Acquired on the Clarity RetCam 3; pediatric retinal photograph (wide-field); 640x480: 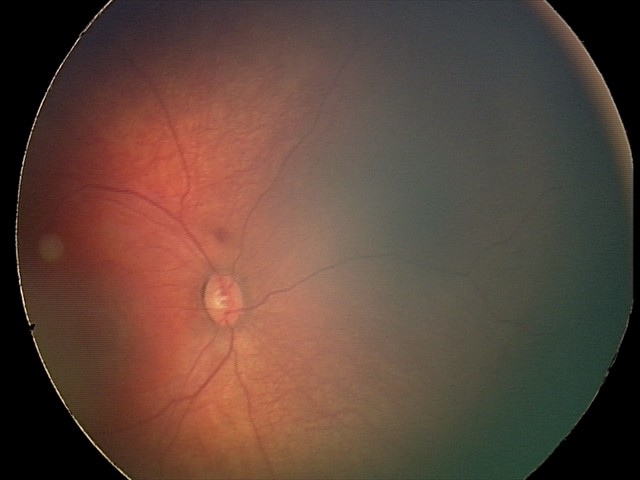

From an examination with diagnosis of retinal hemorrhages.